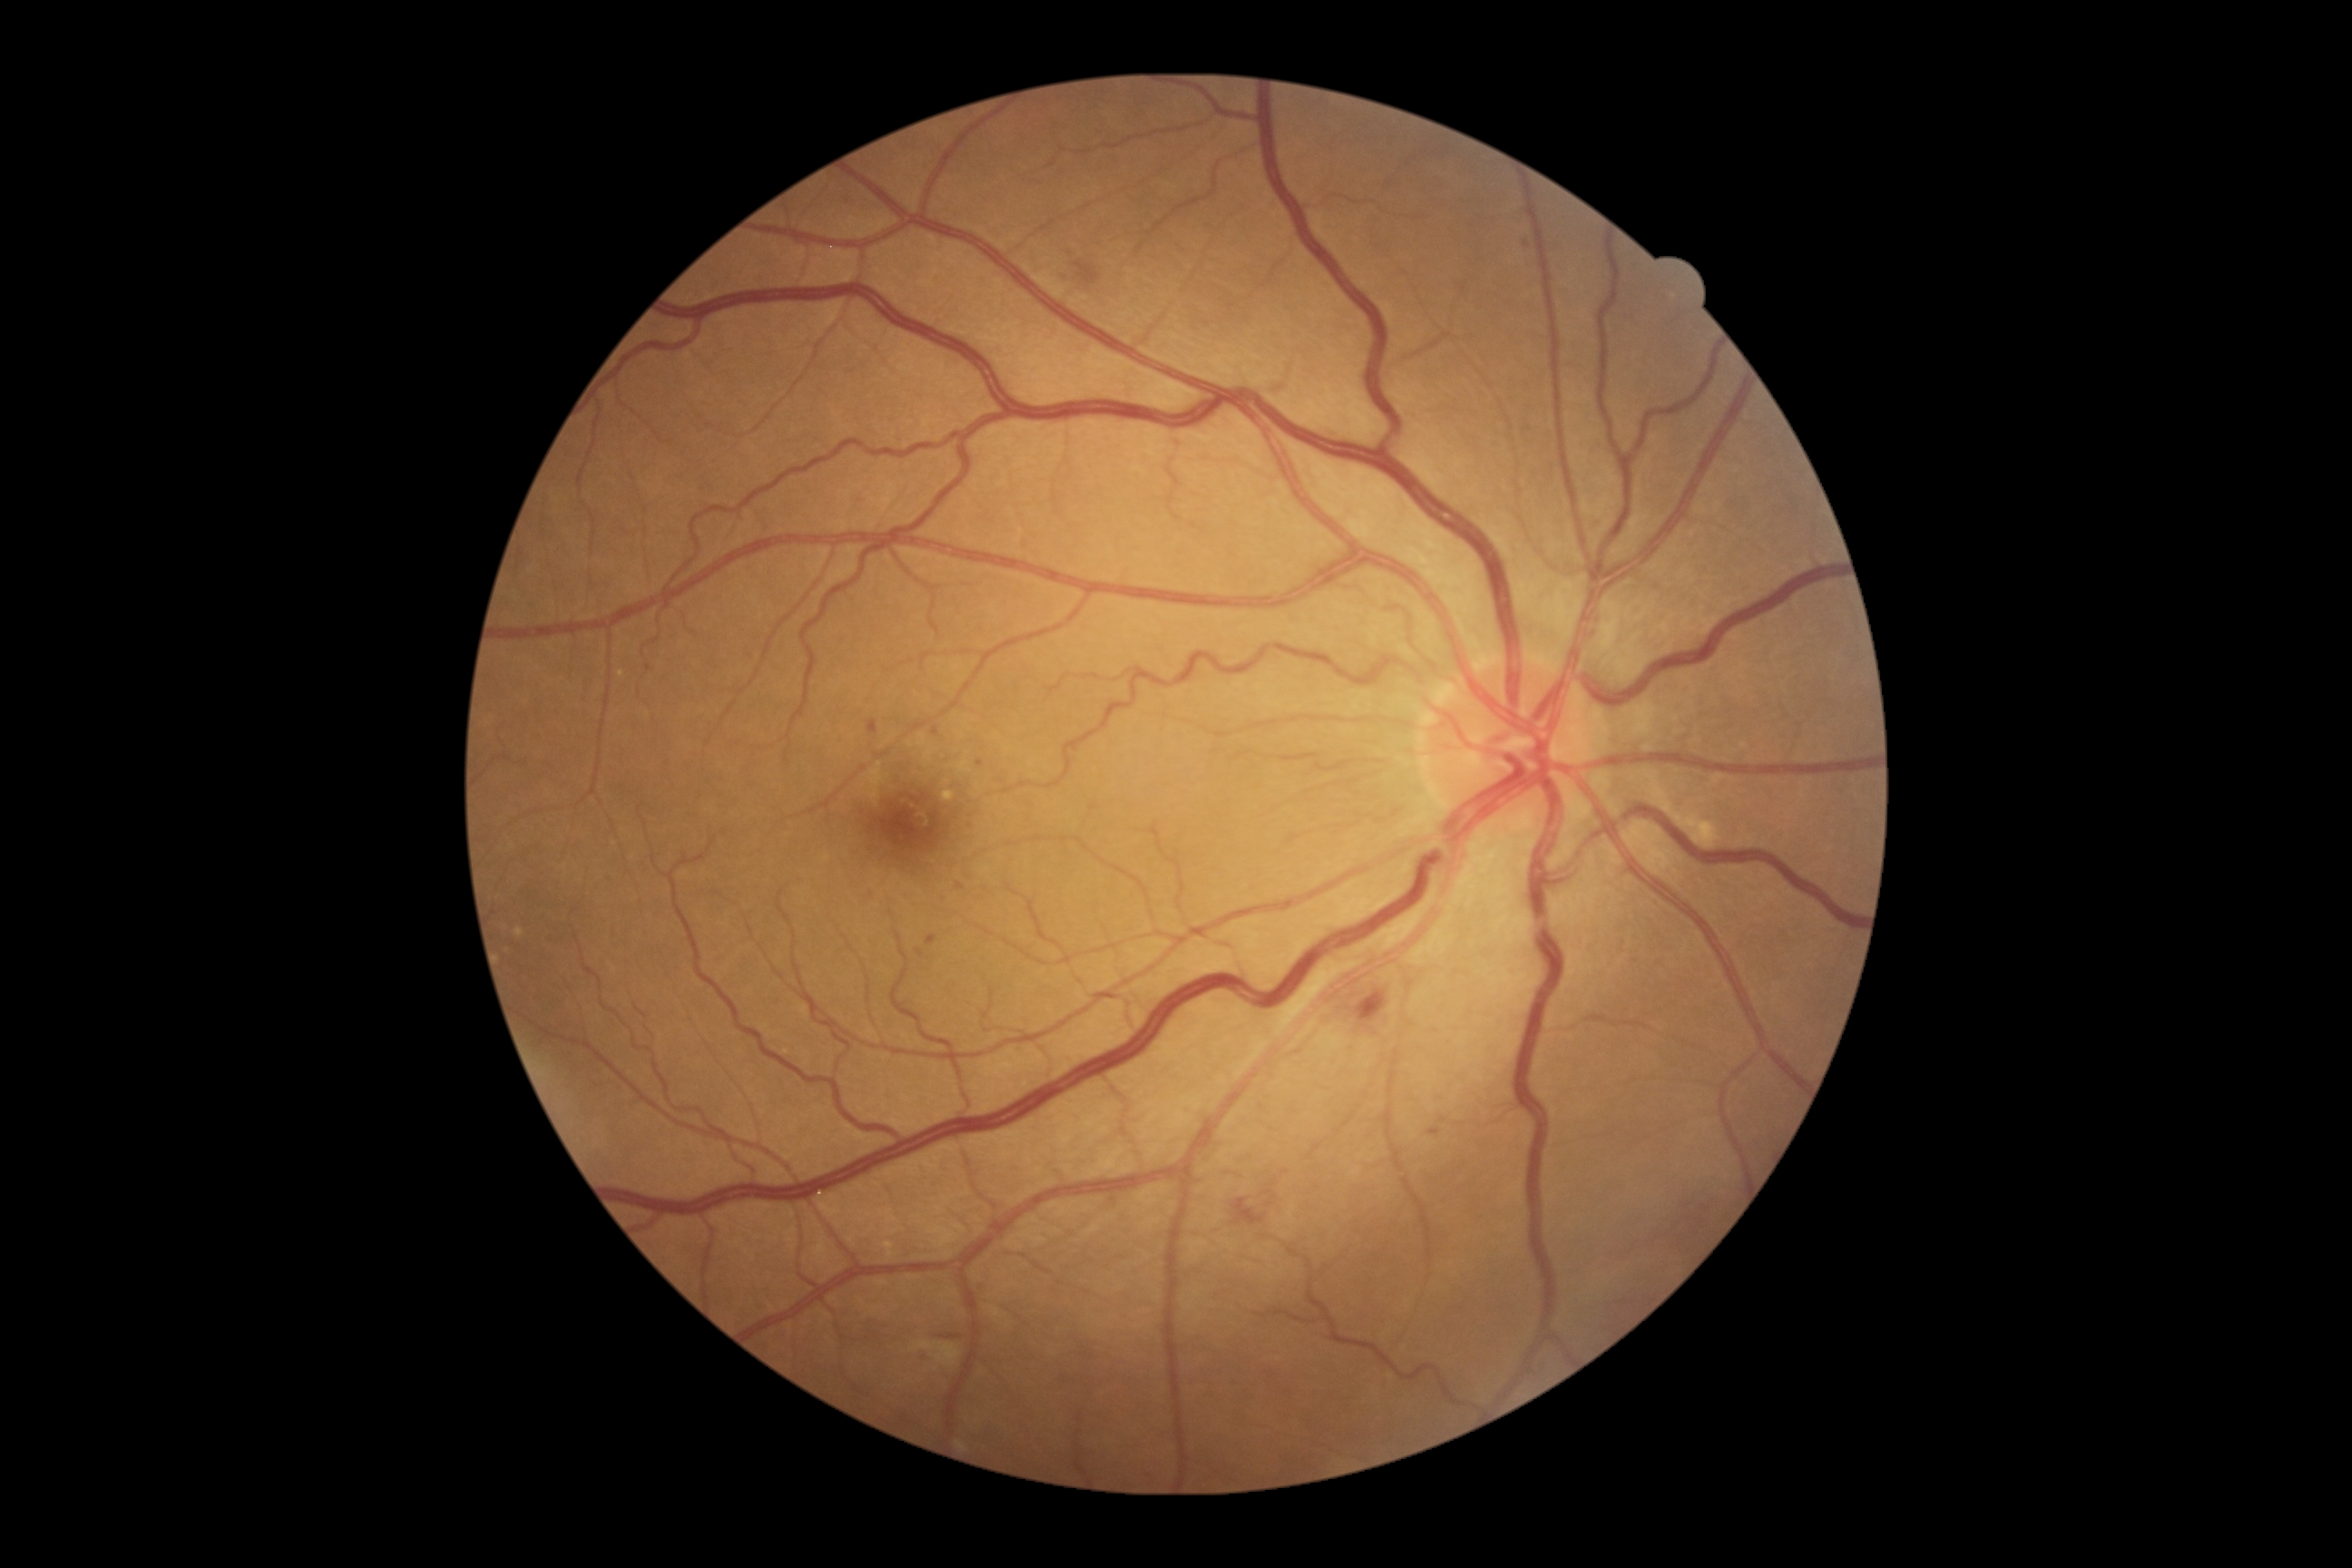

Diabetic retinopathy (DR) is grade 2 (moderate NPDR)
Selected lesions:
microaneurysms (MAs) (subset): region(957, 883, 965, 890) | region(928, 939, 937, 946) | region(977, 760, 985, 767) | region(868, 720, 877, 736) | region(932, 727, 939, 736) | region(1524, 240, 1531, 250)
Smaller MAs around {"x": 1593, "y": 1029}
hard exudates (EXs): region(943, 790, 956, 801)
hemorrhages (HEs): region(1075, 262, 1101, 286) | region(937, 1333, 965, 1340) | region(1351, 990, 1389, 1035) | region(1429, 1128, 1442, 1137) | region(1231, 1199, 1268, 1226)
soft exudates (SEs): region(910, 1340, 936, 1351) | region(936, 1344, 961, 1366)